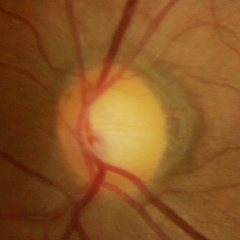
The image shows no glaucomatous optic neuropathy.